Pediatric retinal photograph (wide-field) — 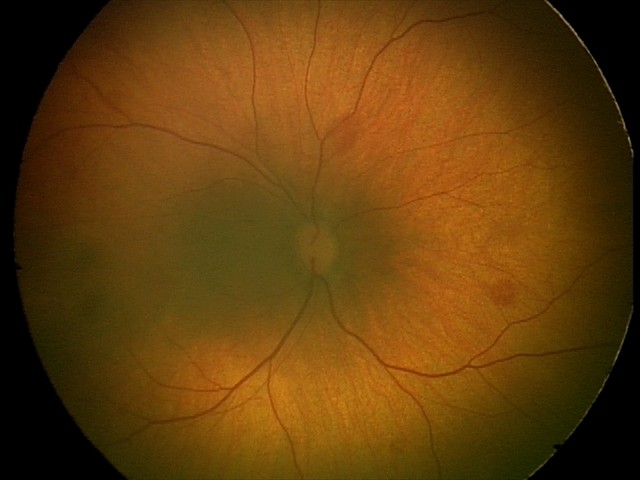 Q: What is the diagnosis from this examination?
A: retinal hemorrhages